Nonmydriatic:
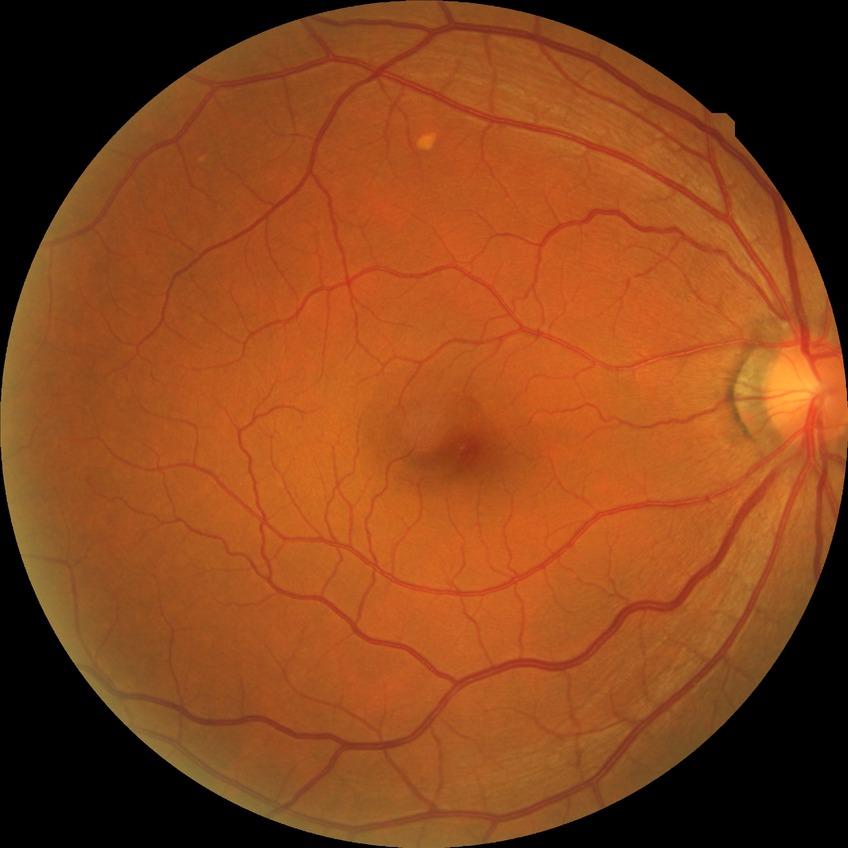

{"davis_grade": "NDR (no diabetic retinopathy)"}